Infant wide-field retinal image:
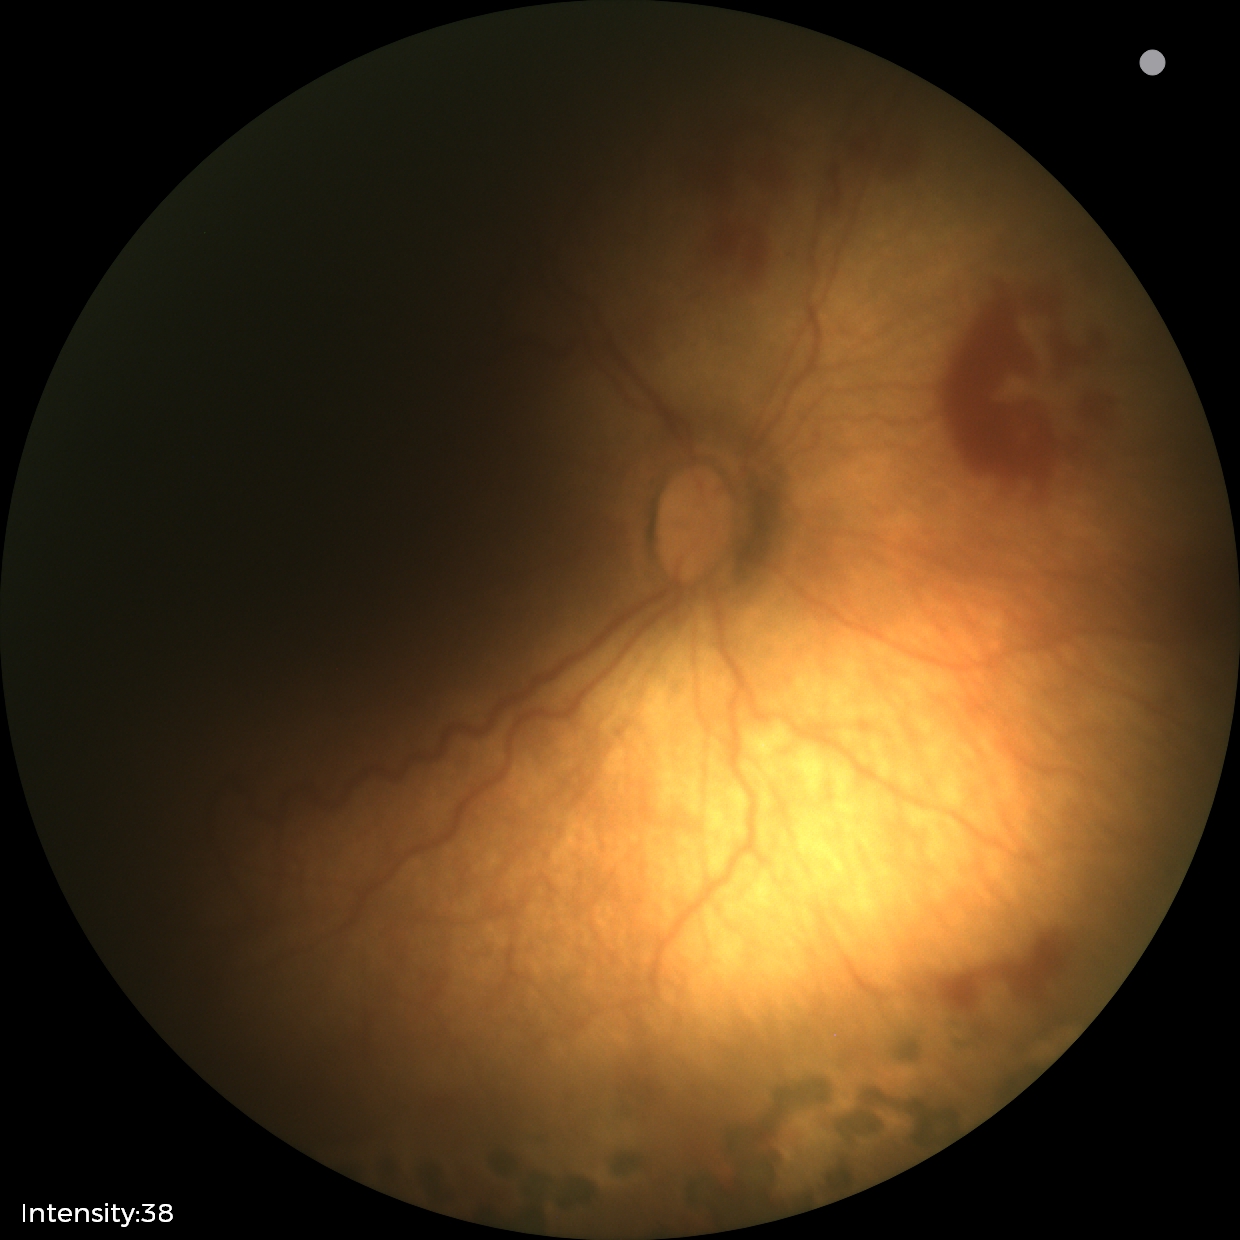

Series diagnosed as status post retinopathy of prematurity.